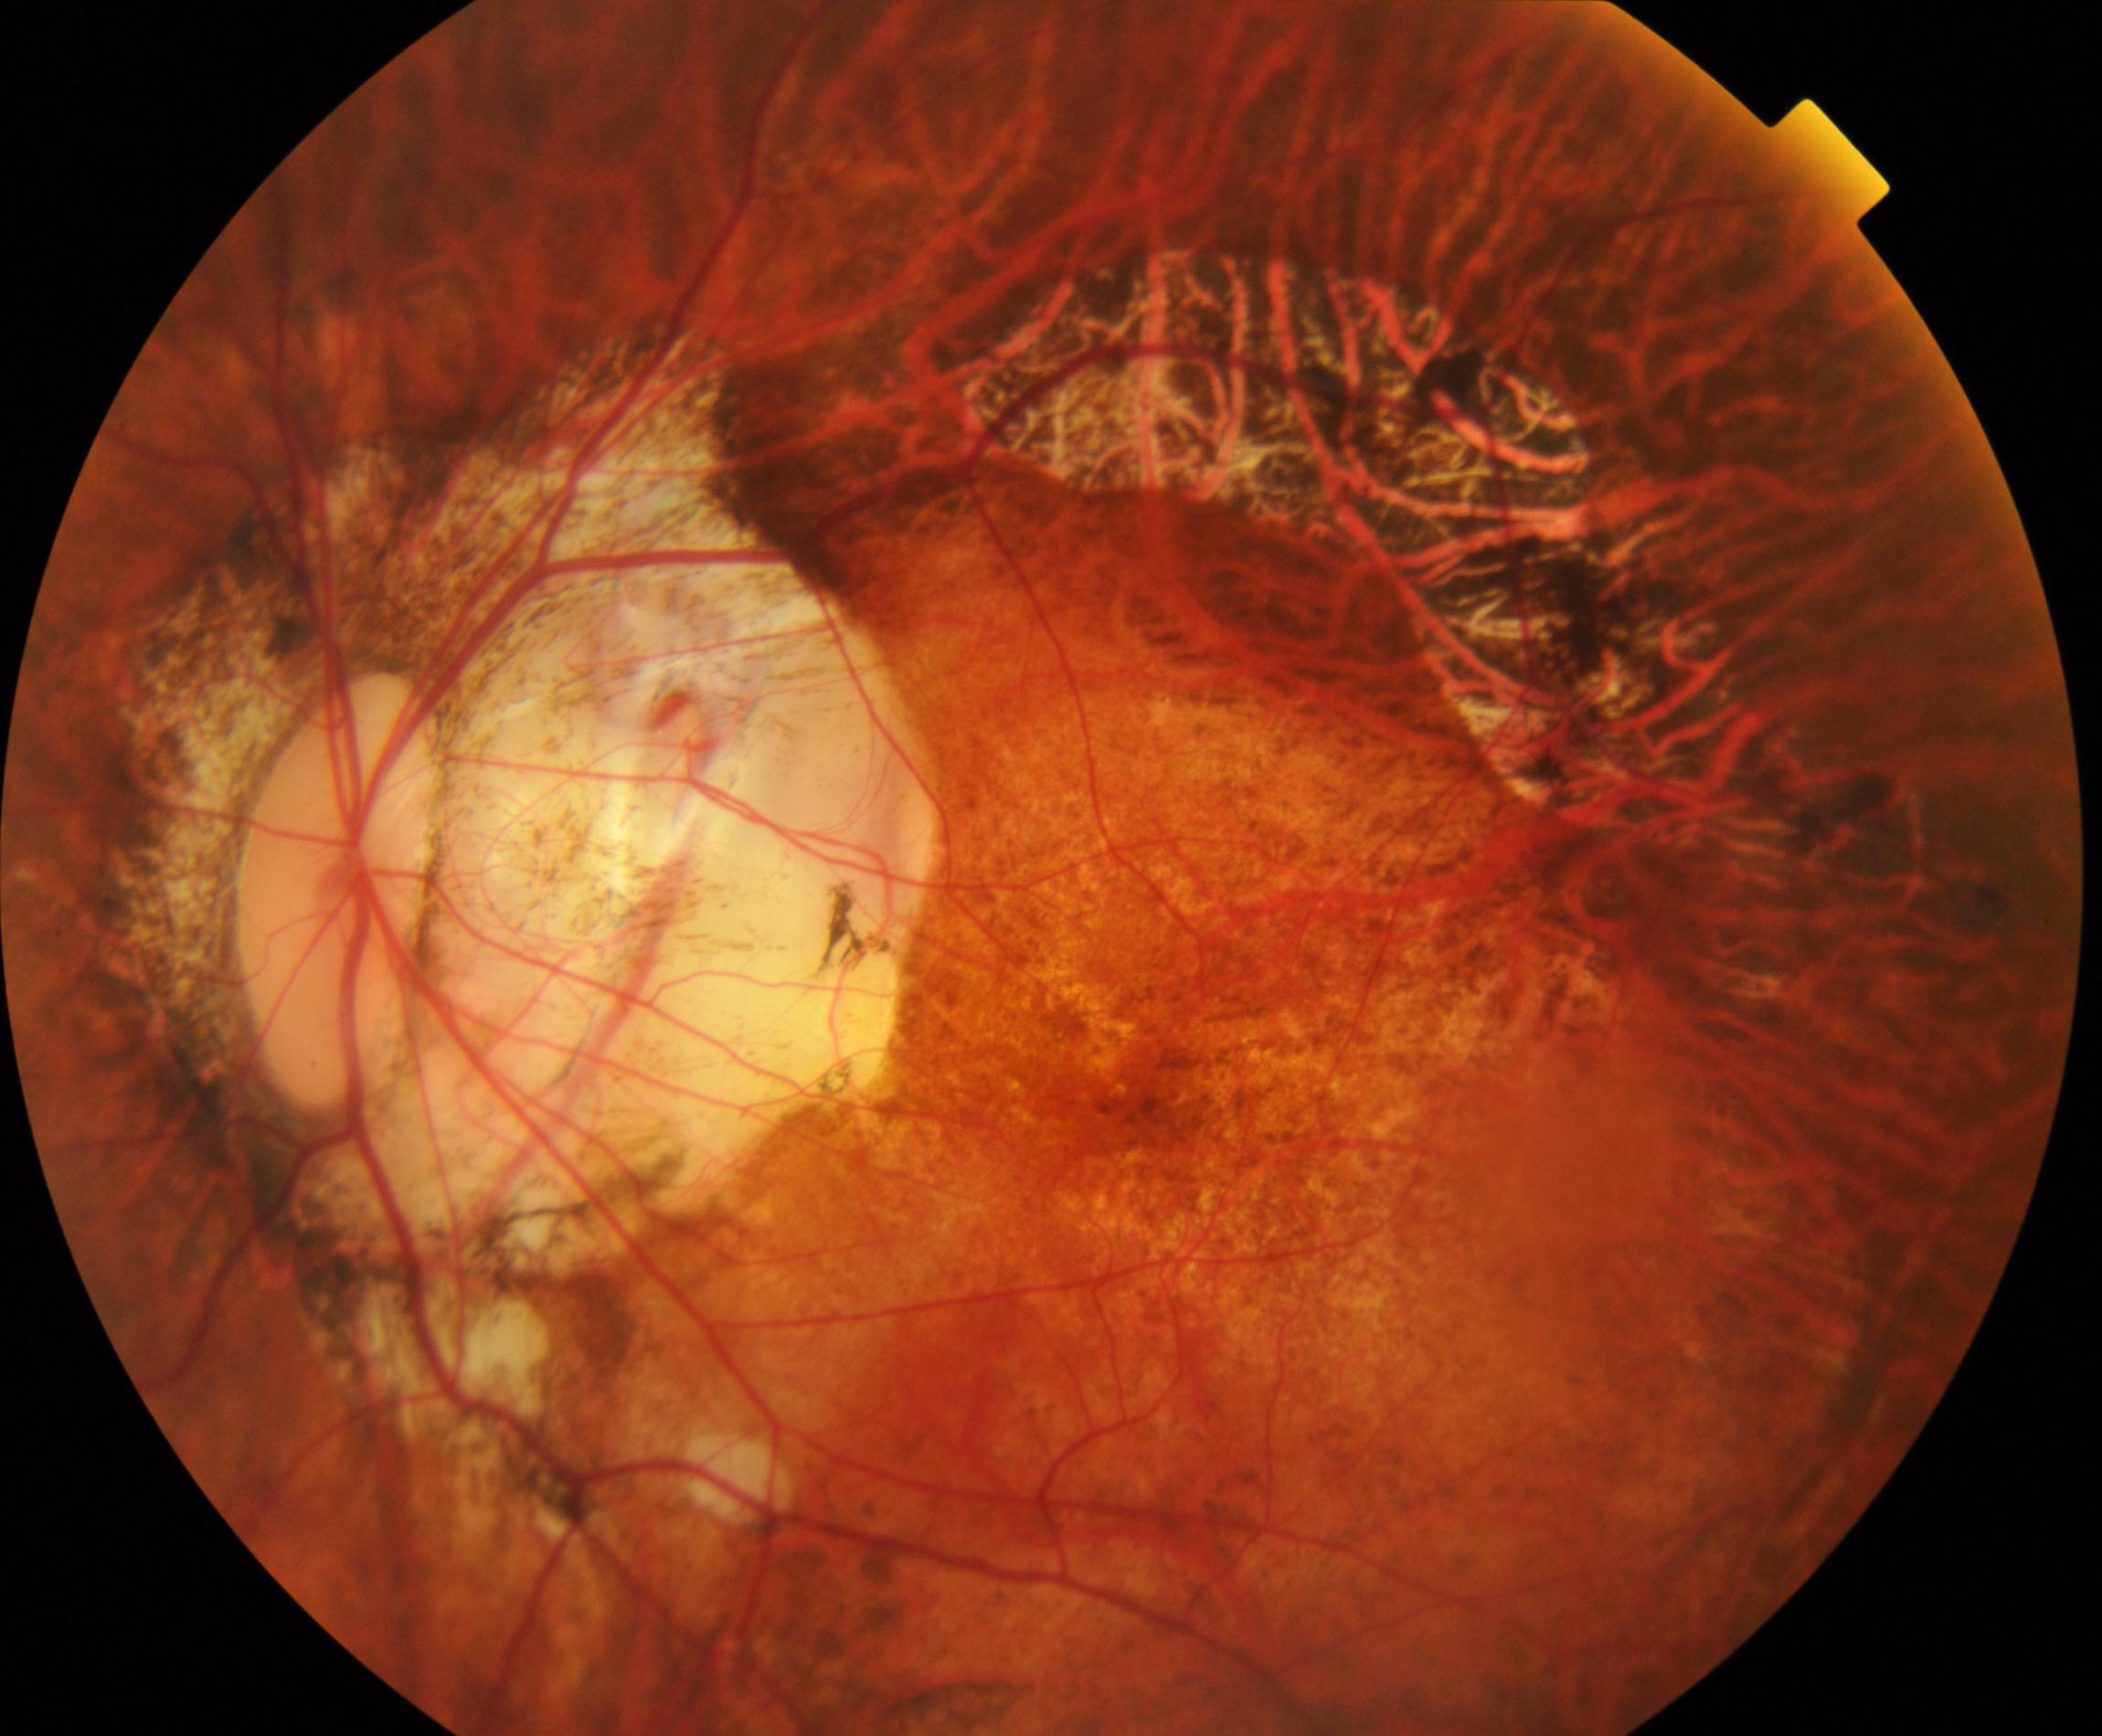 Findings consistent with pathological myopia.